Image size 1469x1472 · fundus photo · 45° FOV: 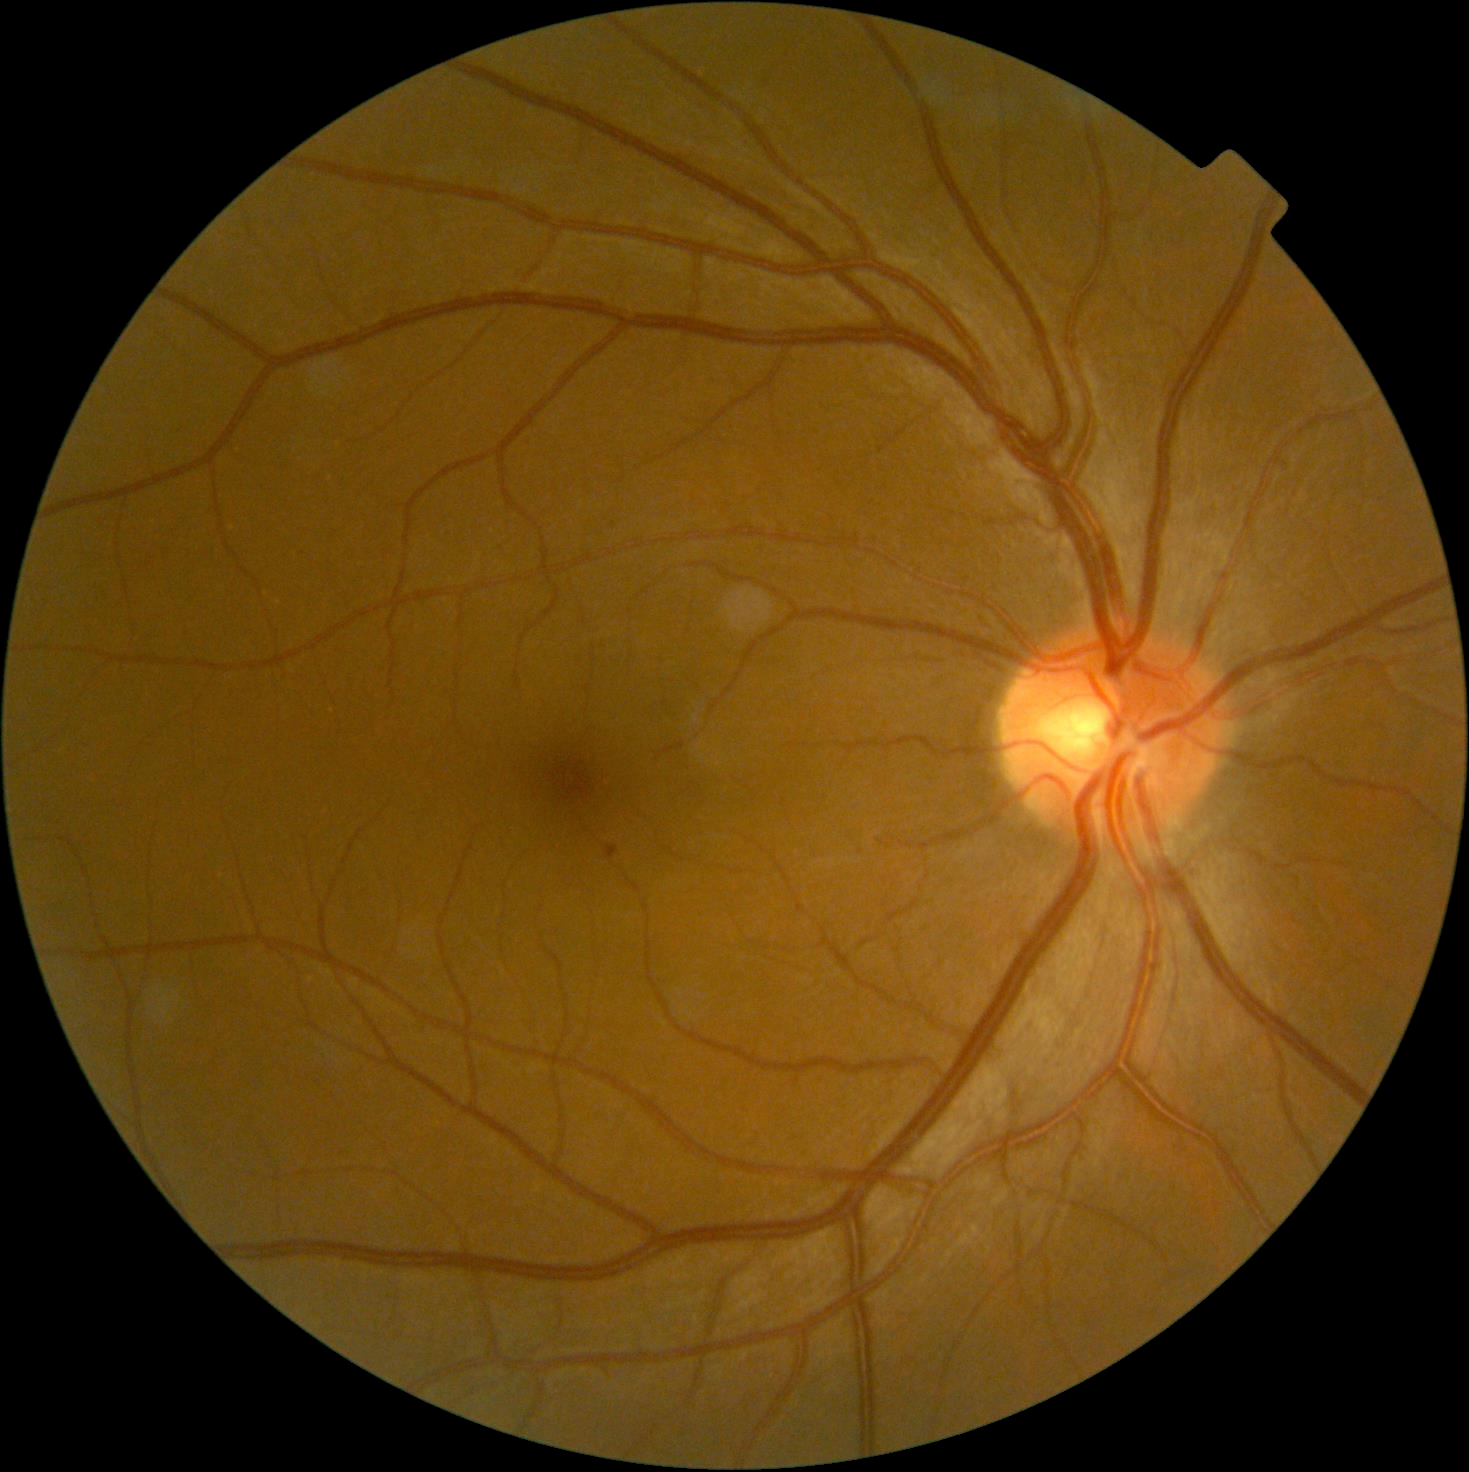
Diabetic retinopathy (DR) is grade 1 (mild NPDR)
hard exudates (EXs): none detected
hemorrhages (HEs): none detected
microaneurysms (MAs): {"left": 606, "top": 845, "right": 619, "bottom": 859}
soft exudates (SEs): none detected